45° FOV · nonmydriatic fundus photograph · camera: NIDEK AFC-230
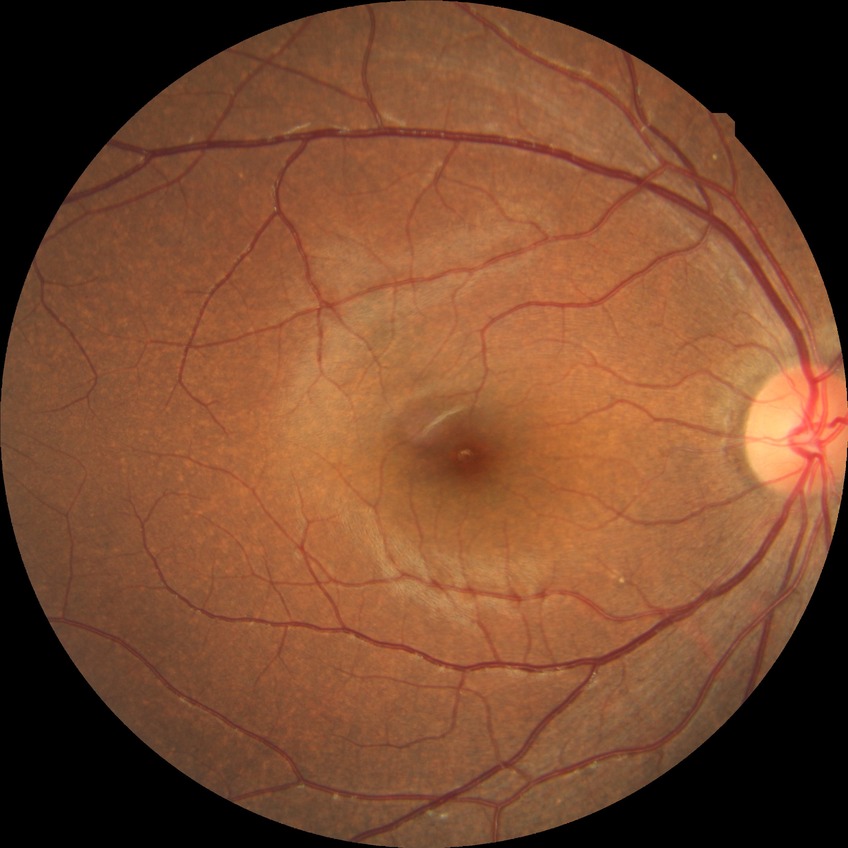
Modified Davis classification is no diabetic retinopathy.